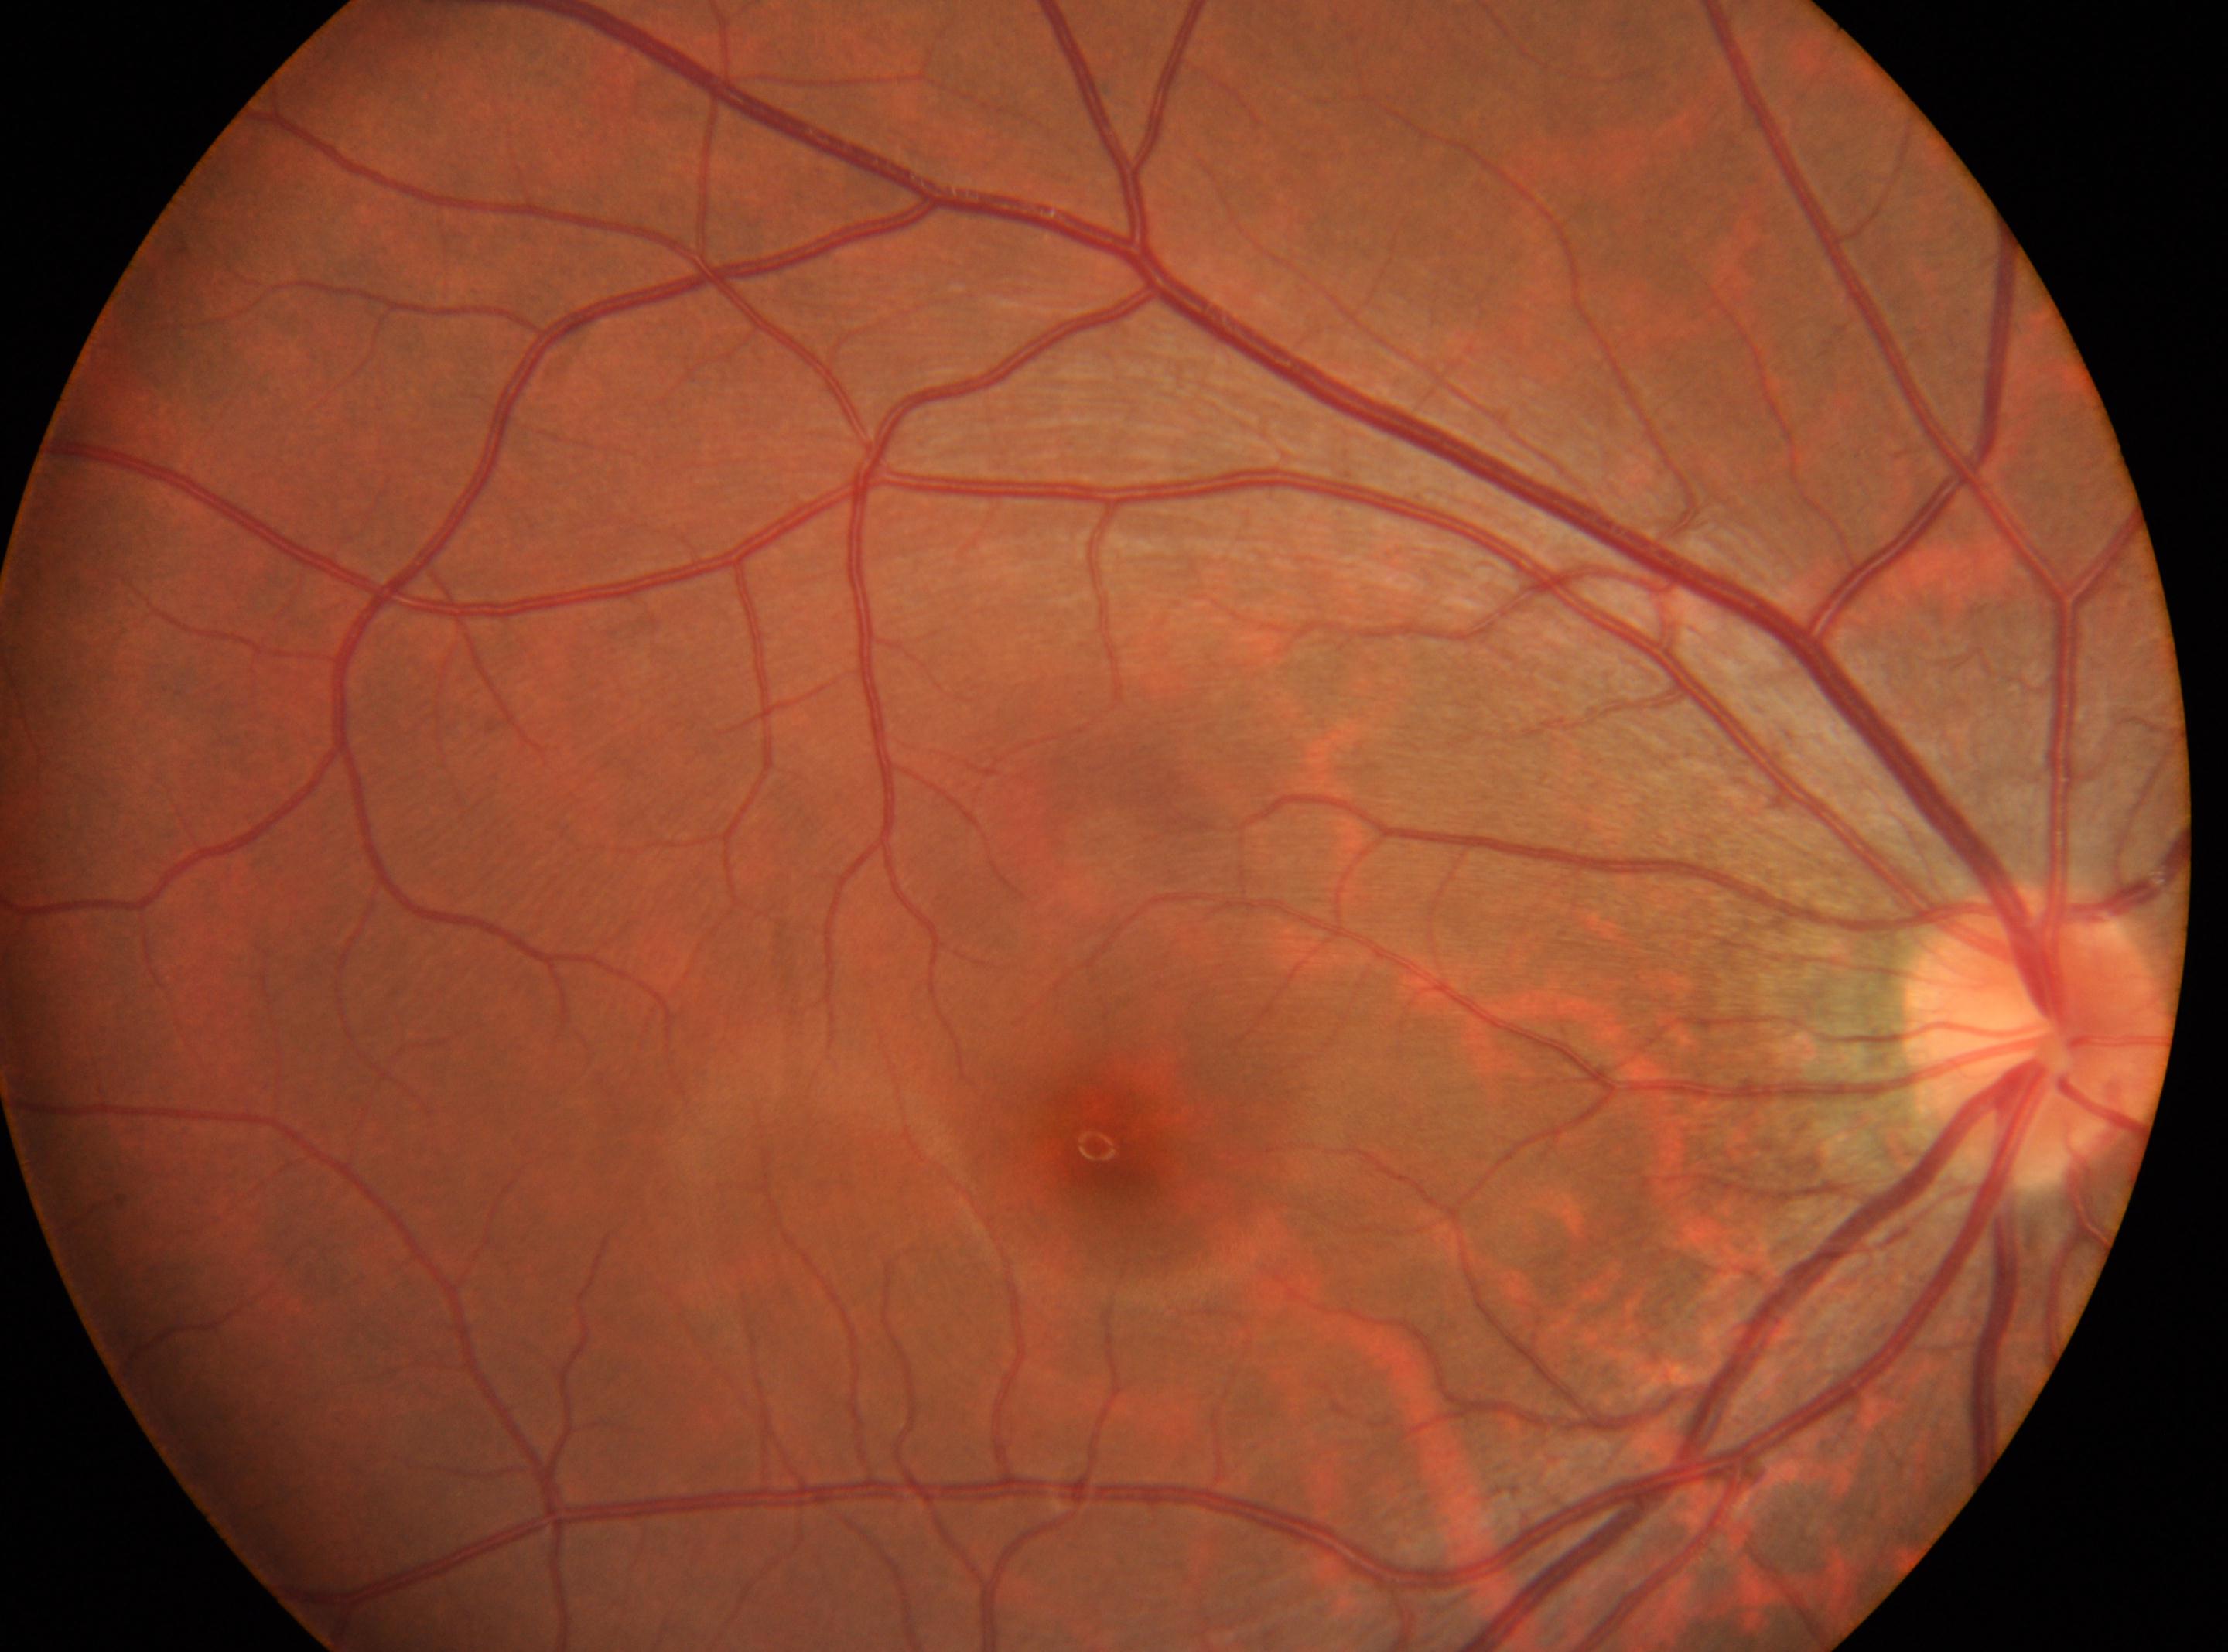

DR grade is 0. The ONH is at 2035px, 1031px. The fovea centralis is at 1103px, 1146px. Eye: right.